Captured with the Natus RetCam Envision (130° field of view); wide-field contact fundus photograph of an infant:
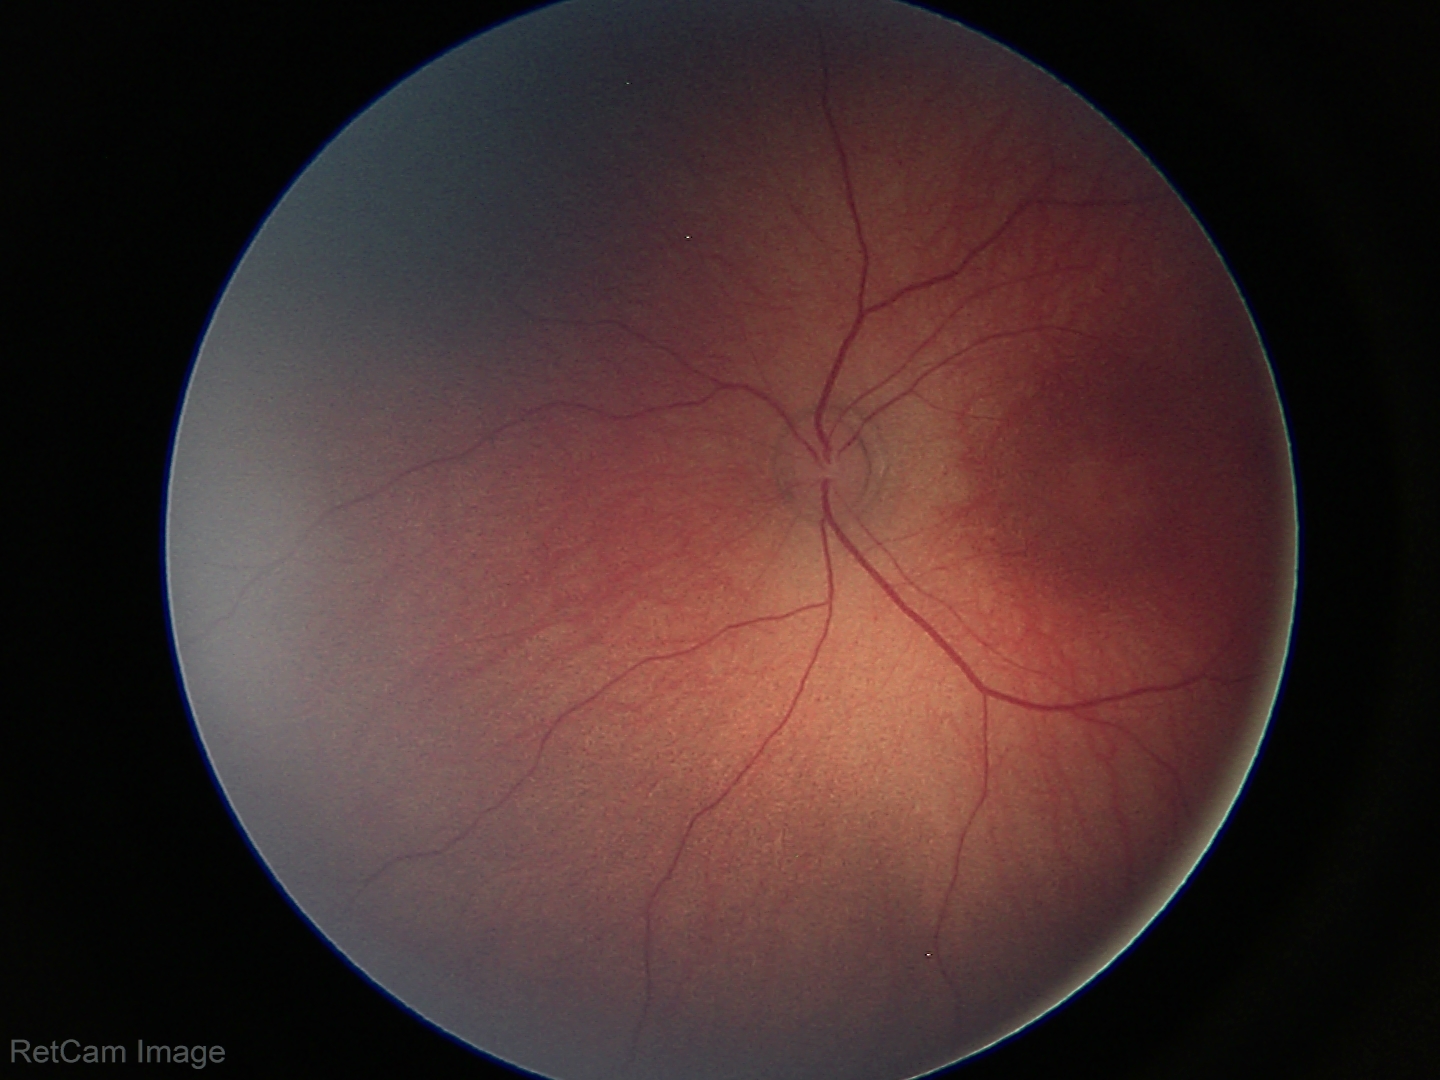 Physiological retinal appearance for postconceptual age.